1924x1556px · ultra-widefield fundus mosaic · 200° field of view:
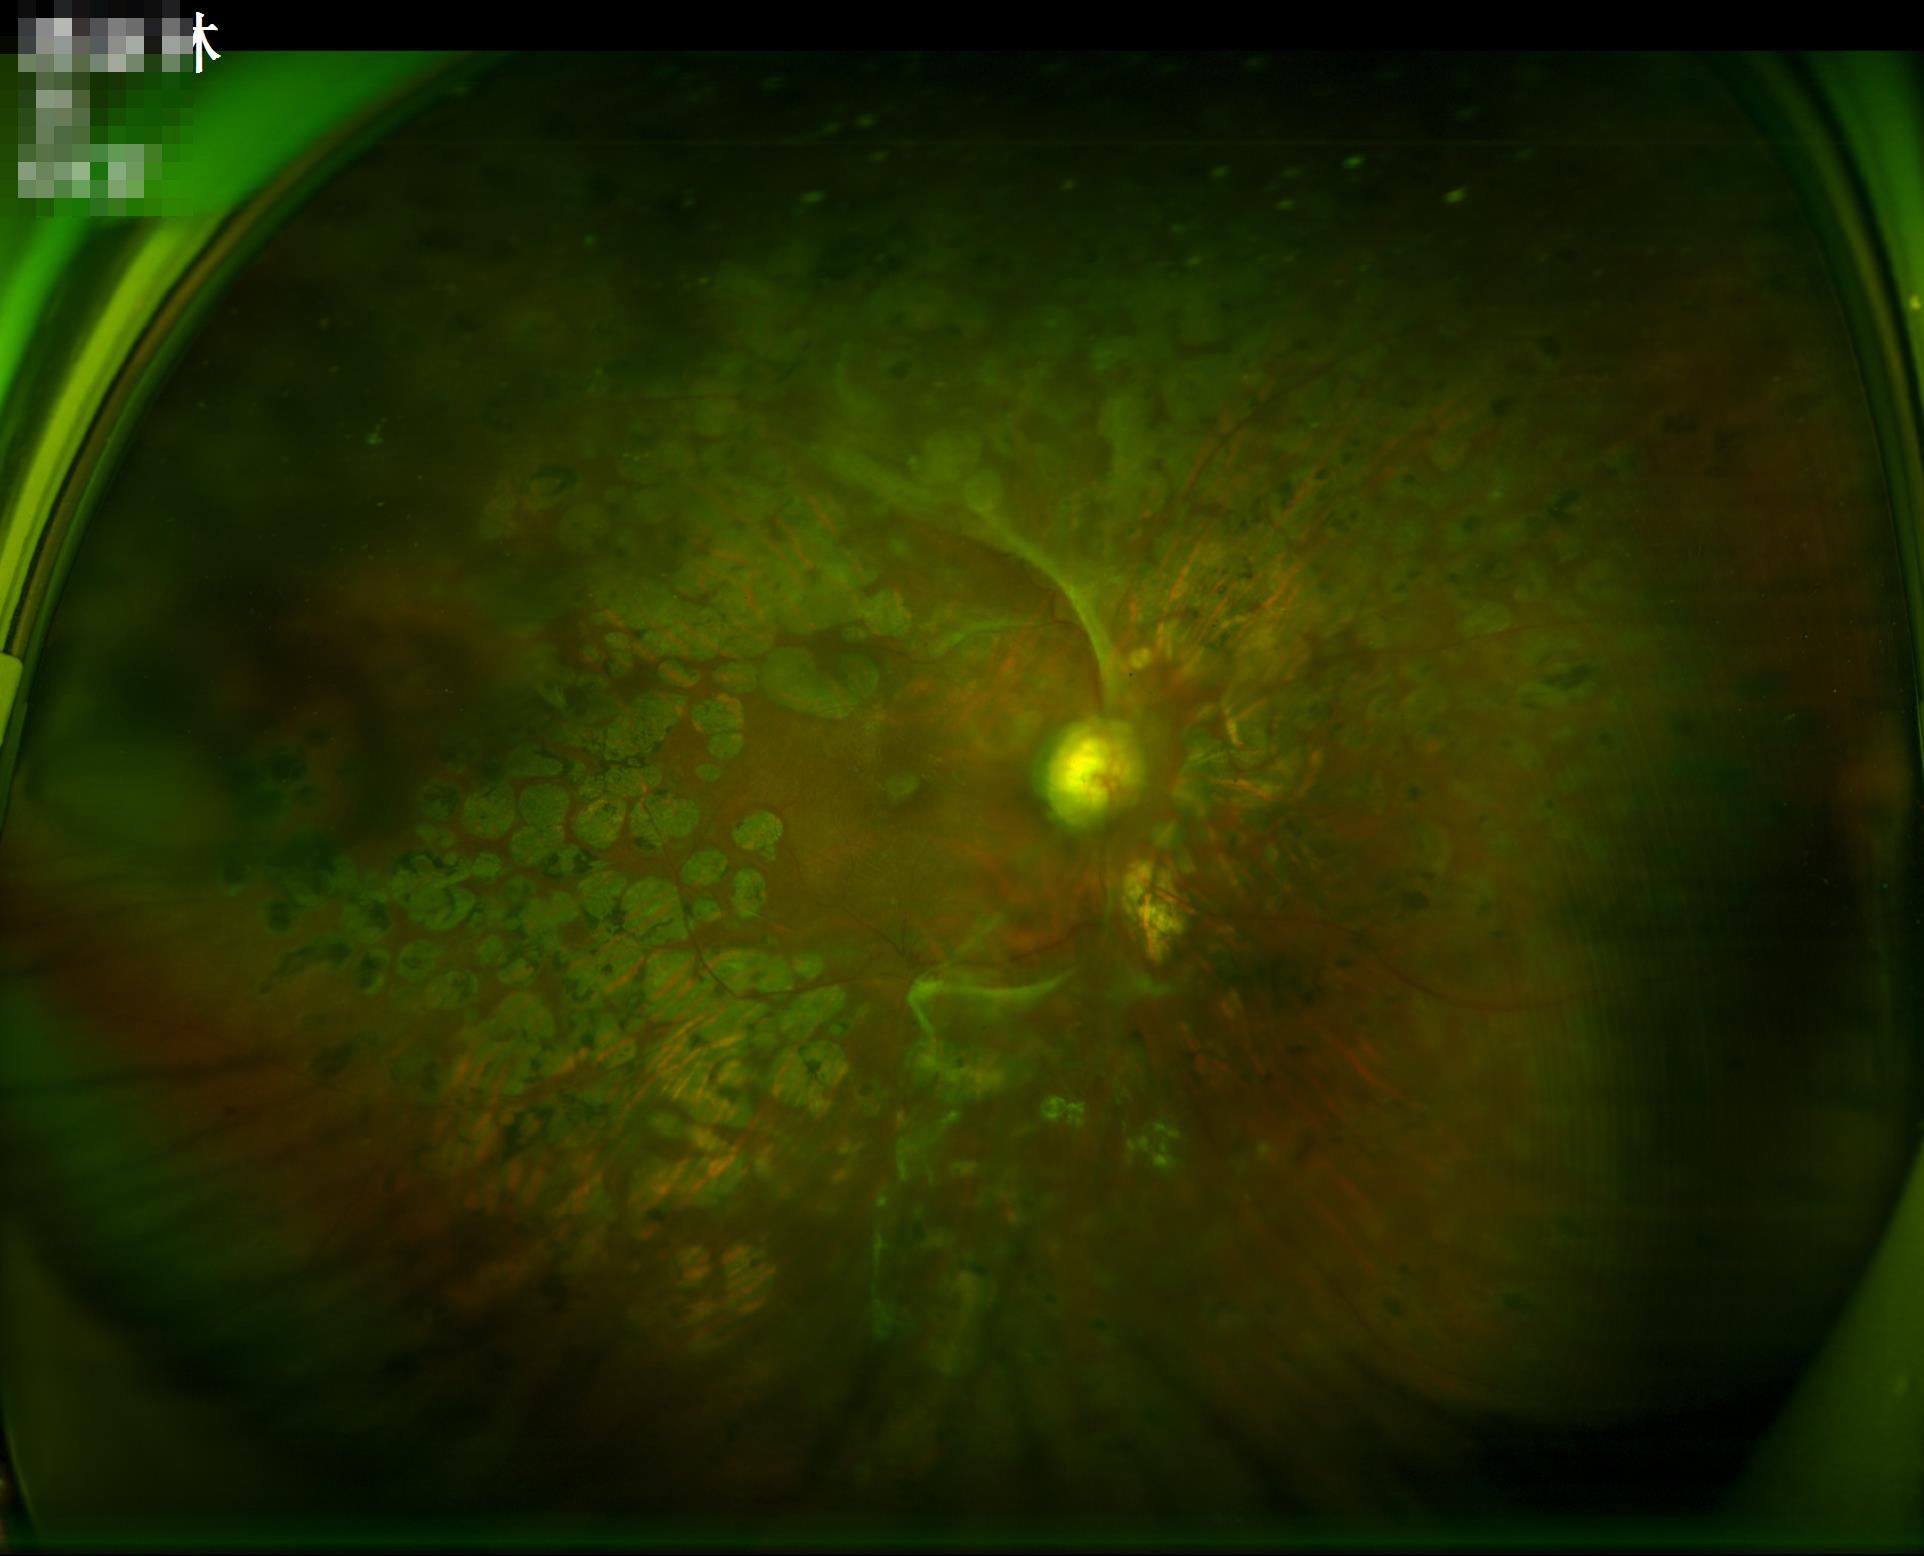
Illumination = even
Overall = low
Clarity = reduced
Contrast = poor